Non-mydriatic fundus camera: 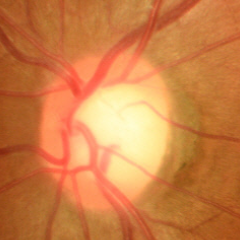
Glaucoma stage: no glaucoma.